Modified Davis classification: 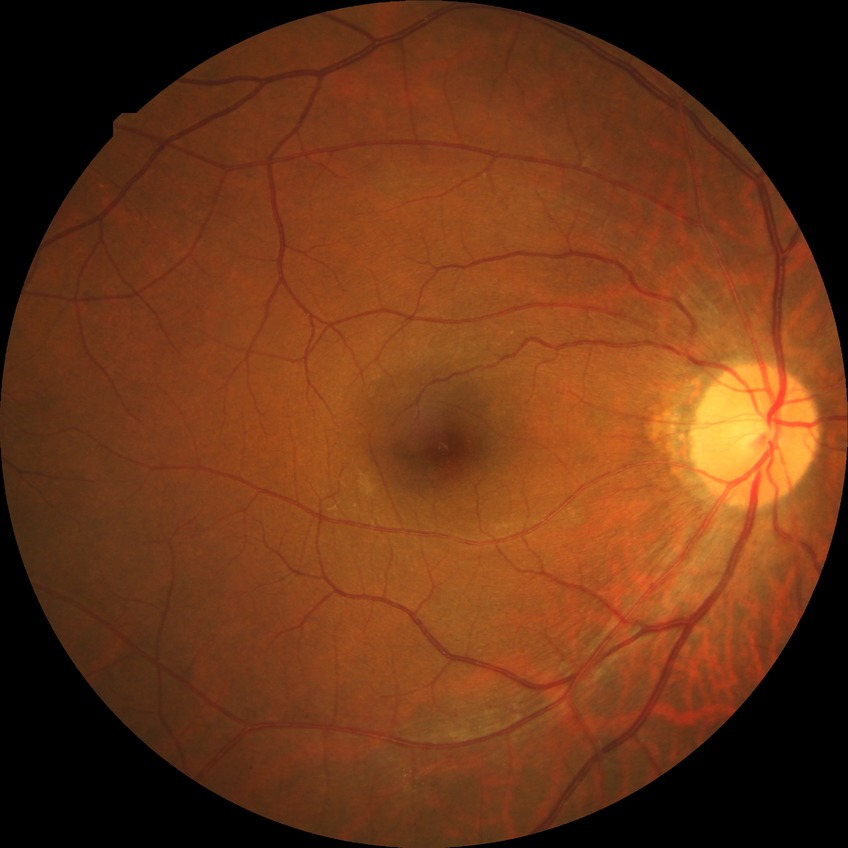
Diabetic retinopathy (DR) is no diabetic retinopathy (NDR).